1240 x 1240 pixels. Pediatric wide-field fundus photograph
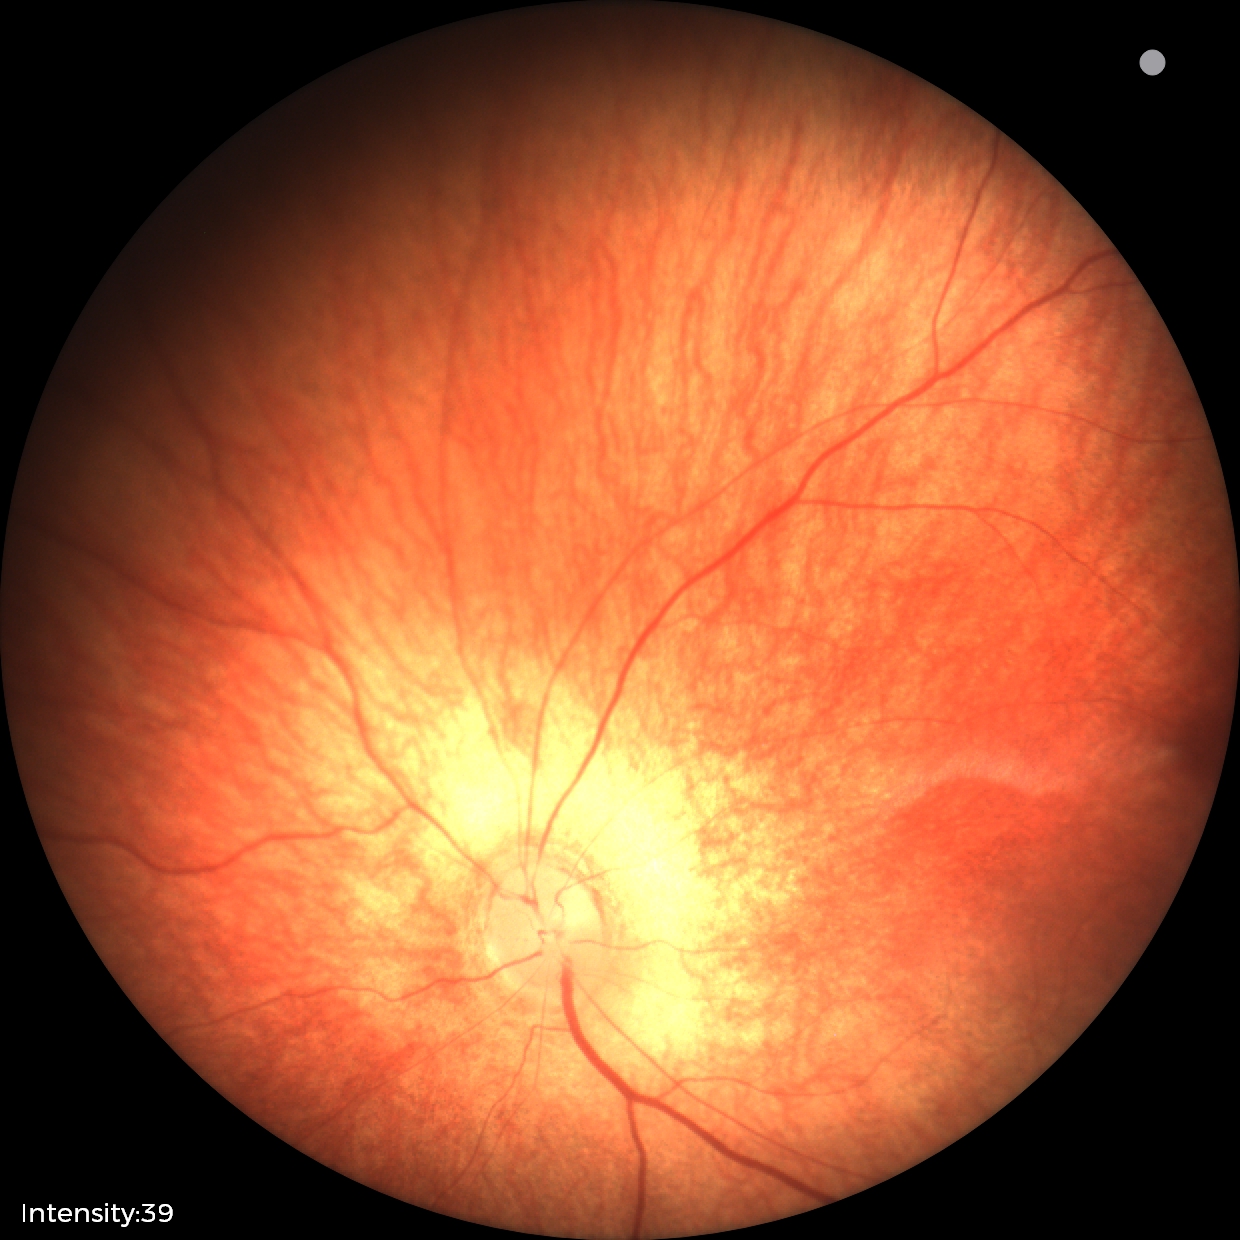 Impression = physiological appearance.